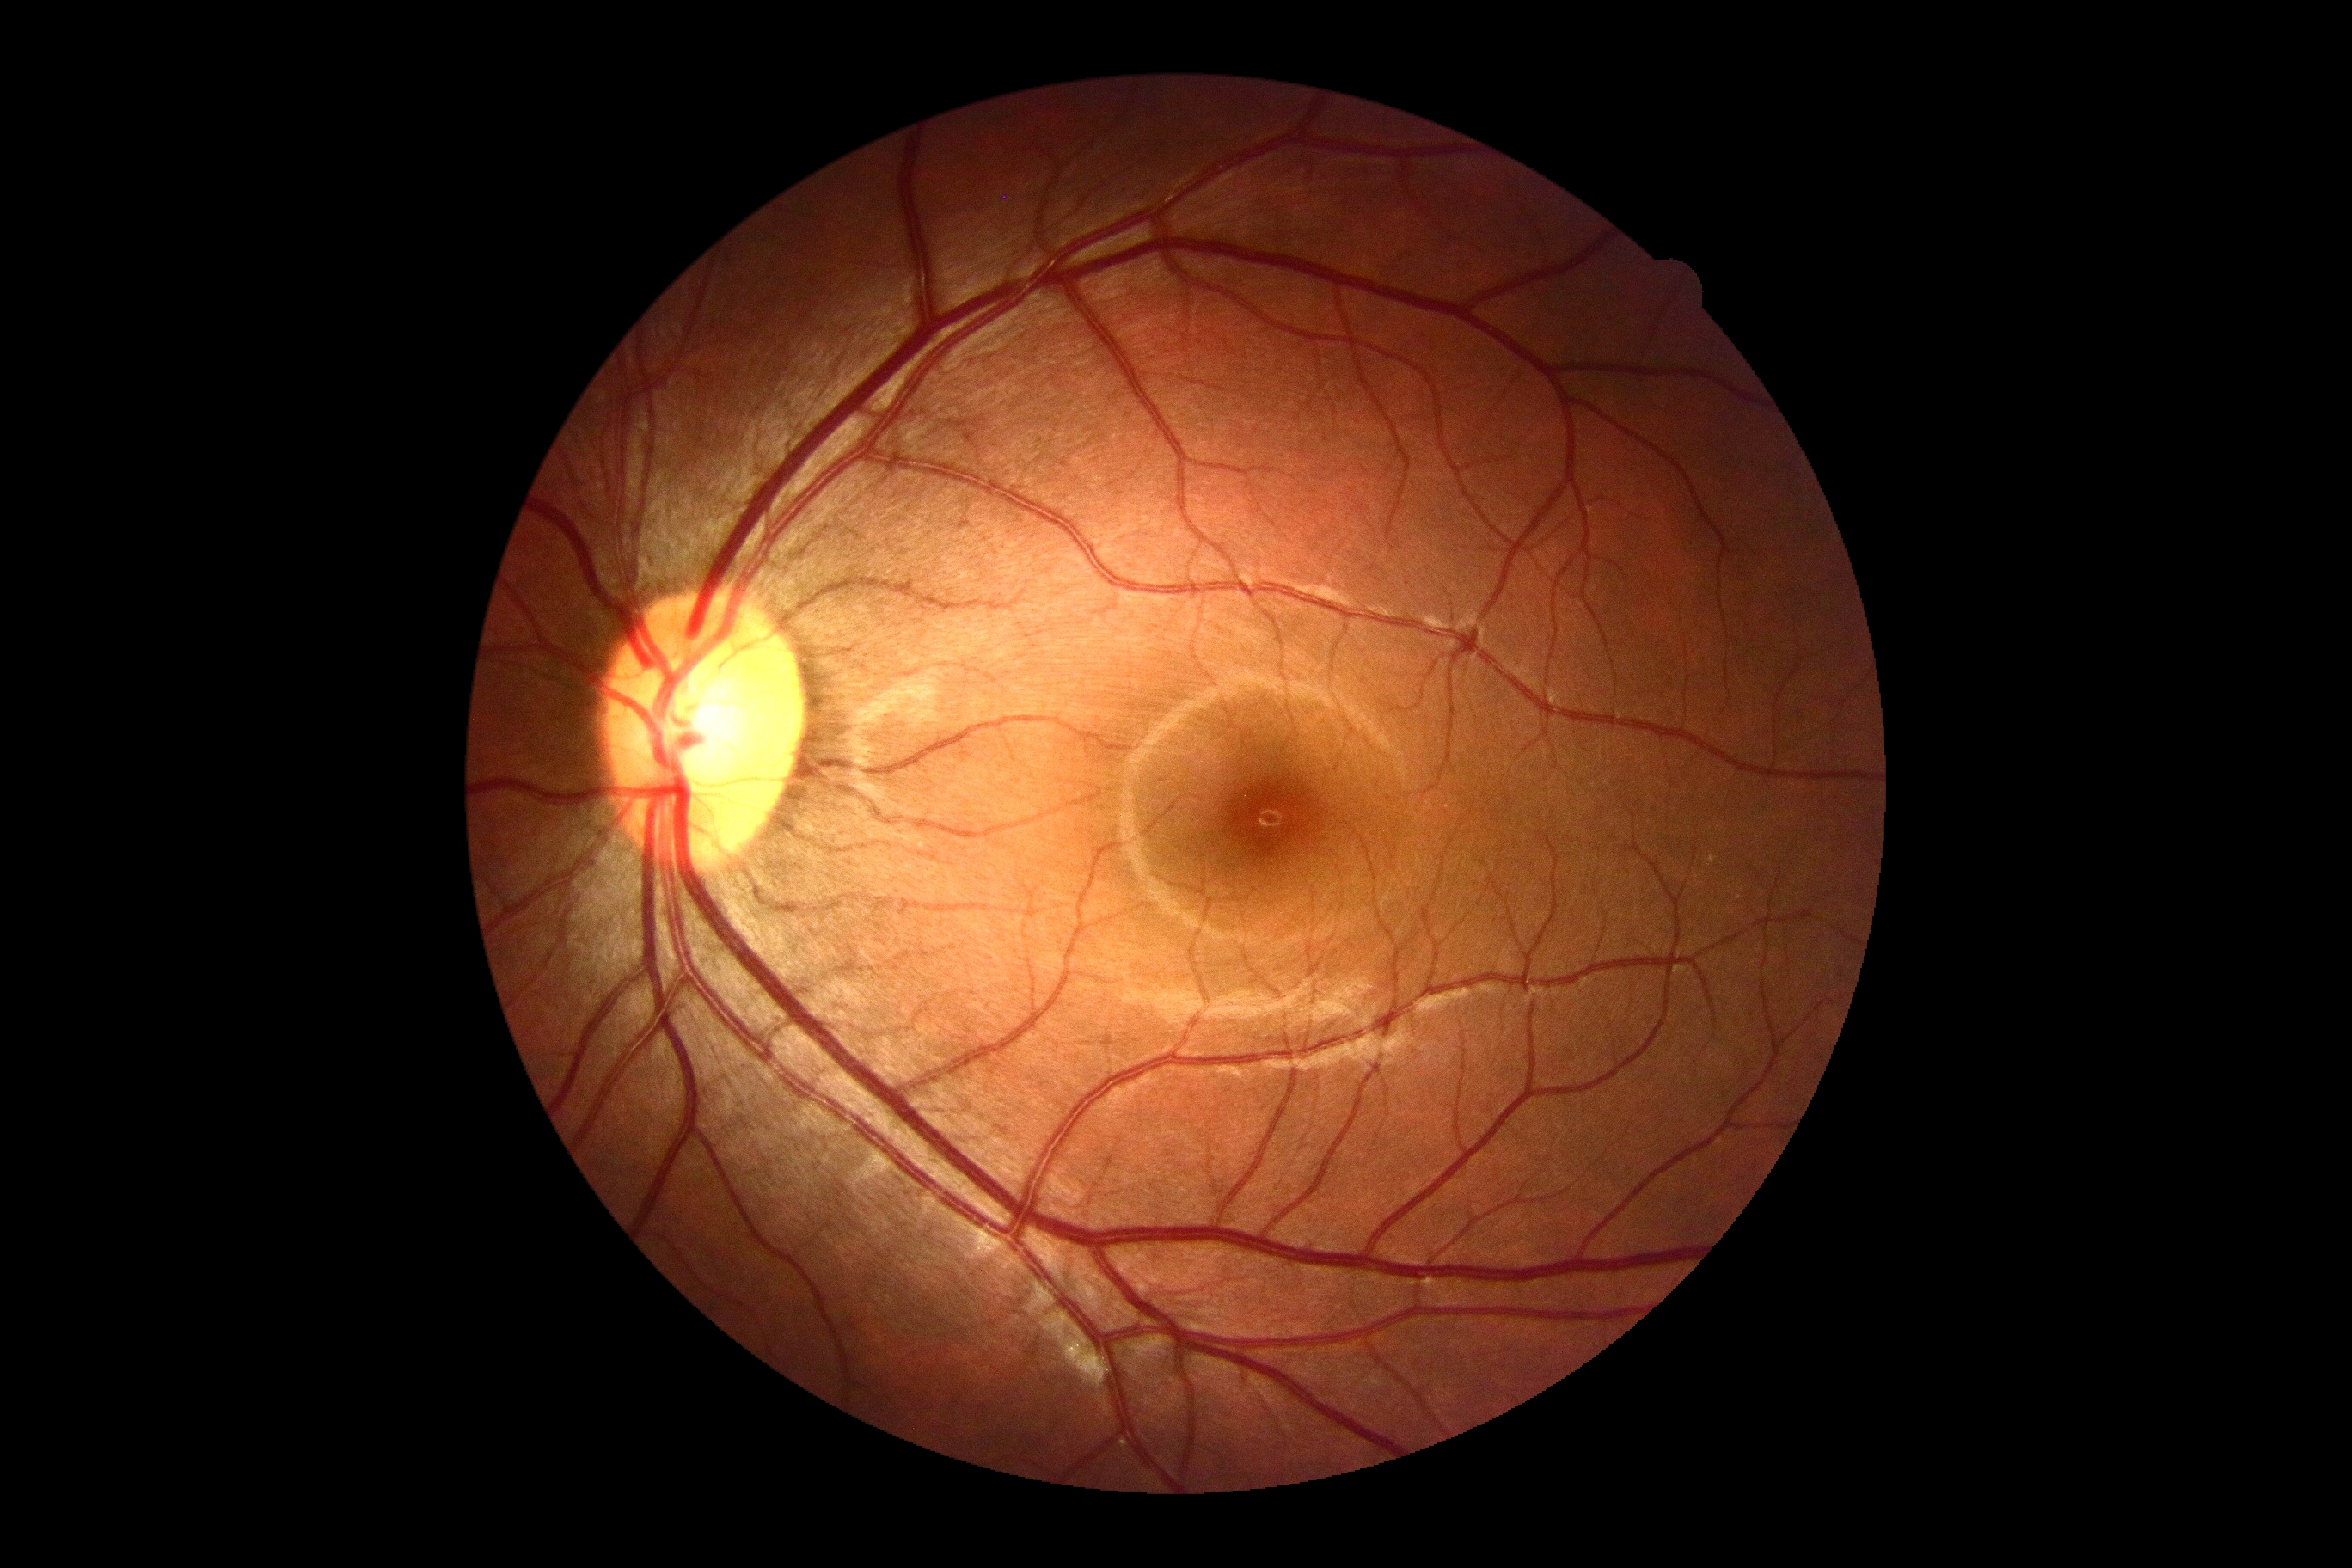 Retinopathy grade: 0.